Acquired with a Remidio Fundus on Phone. CFP:
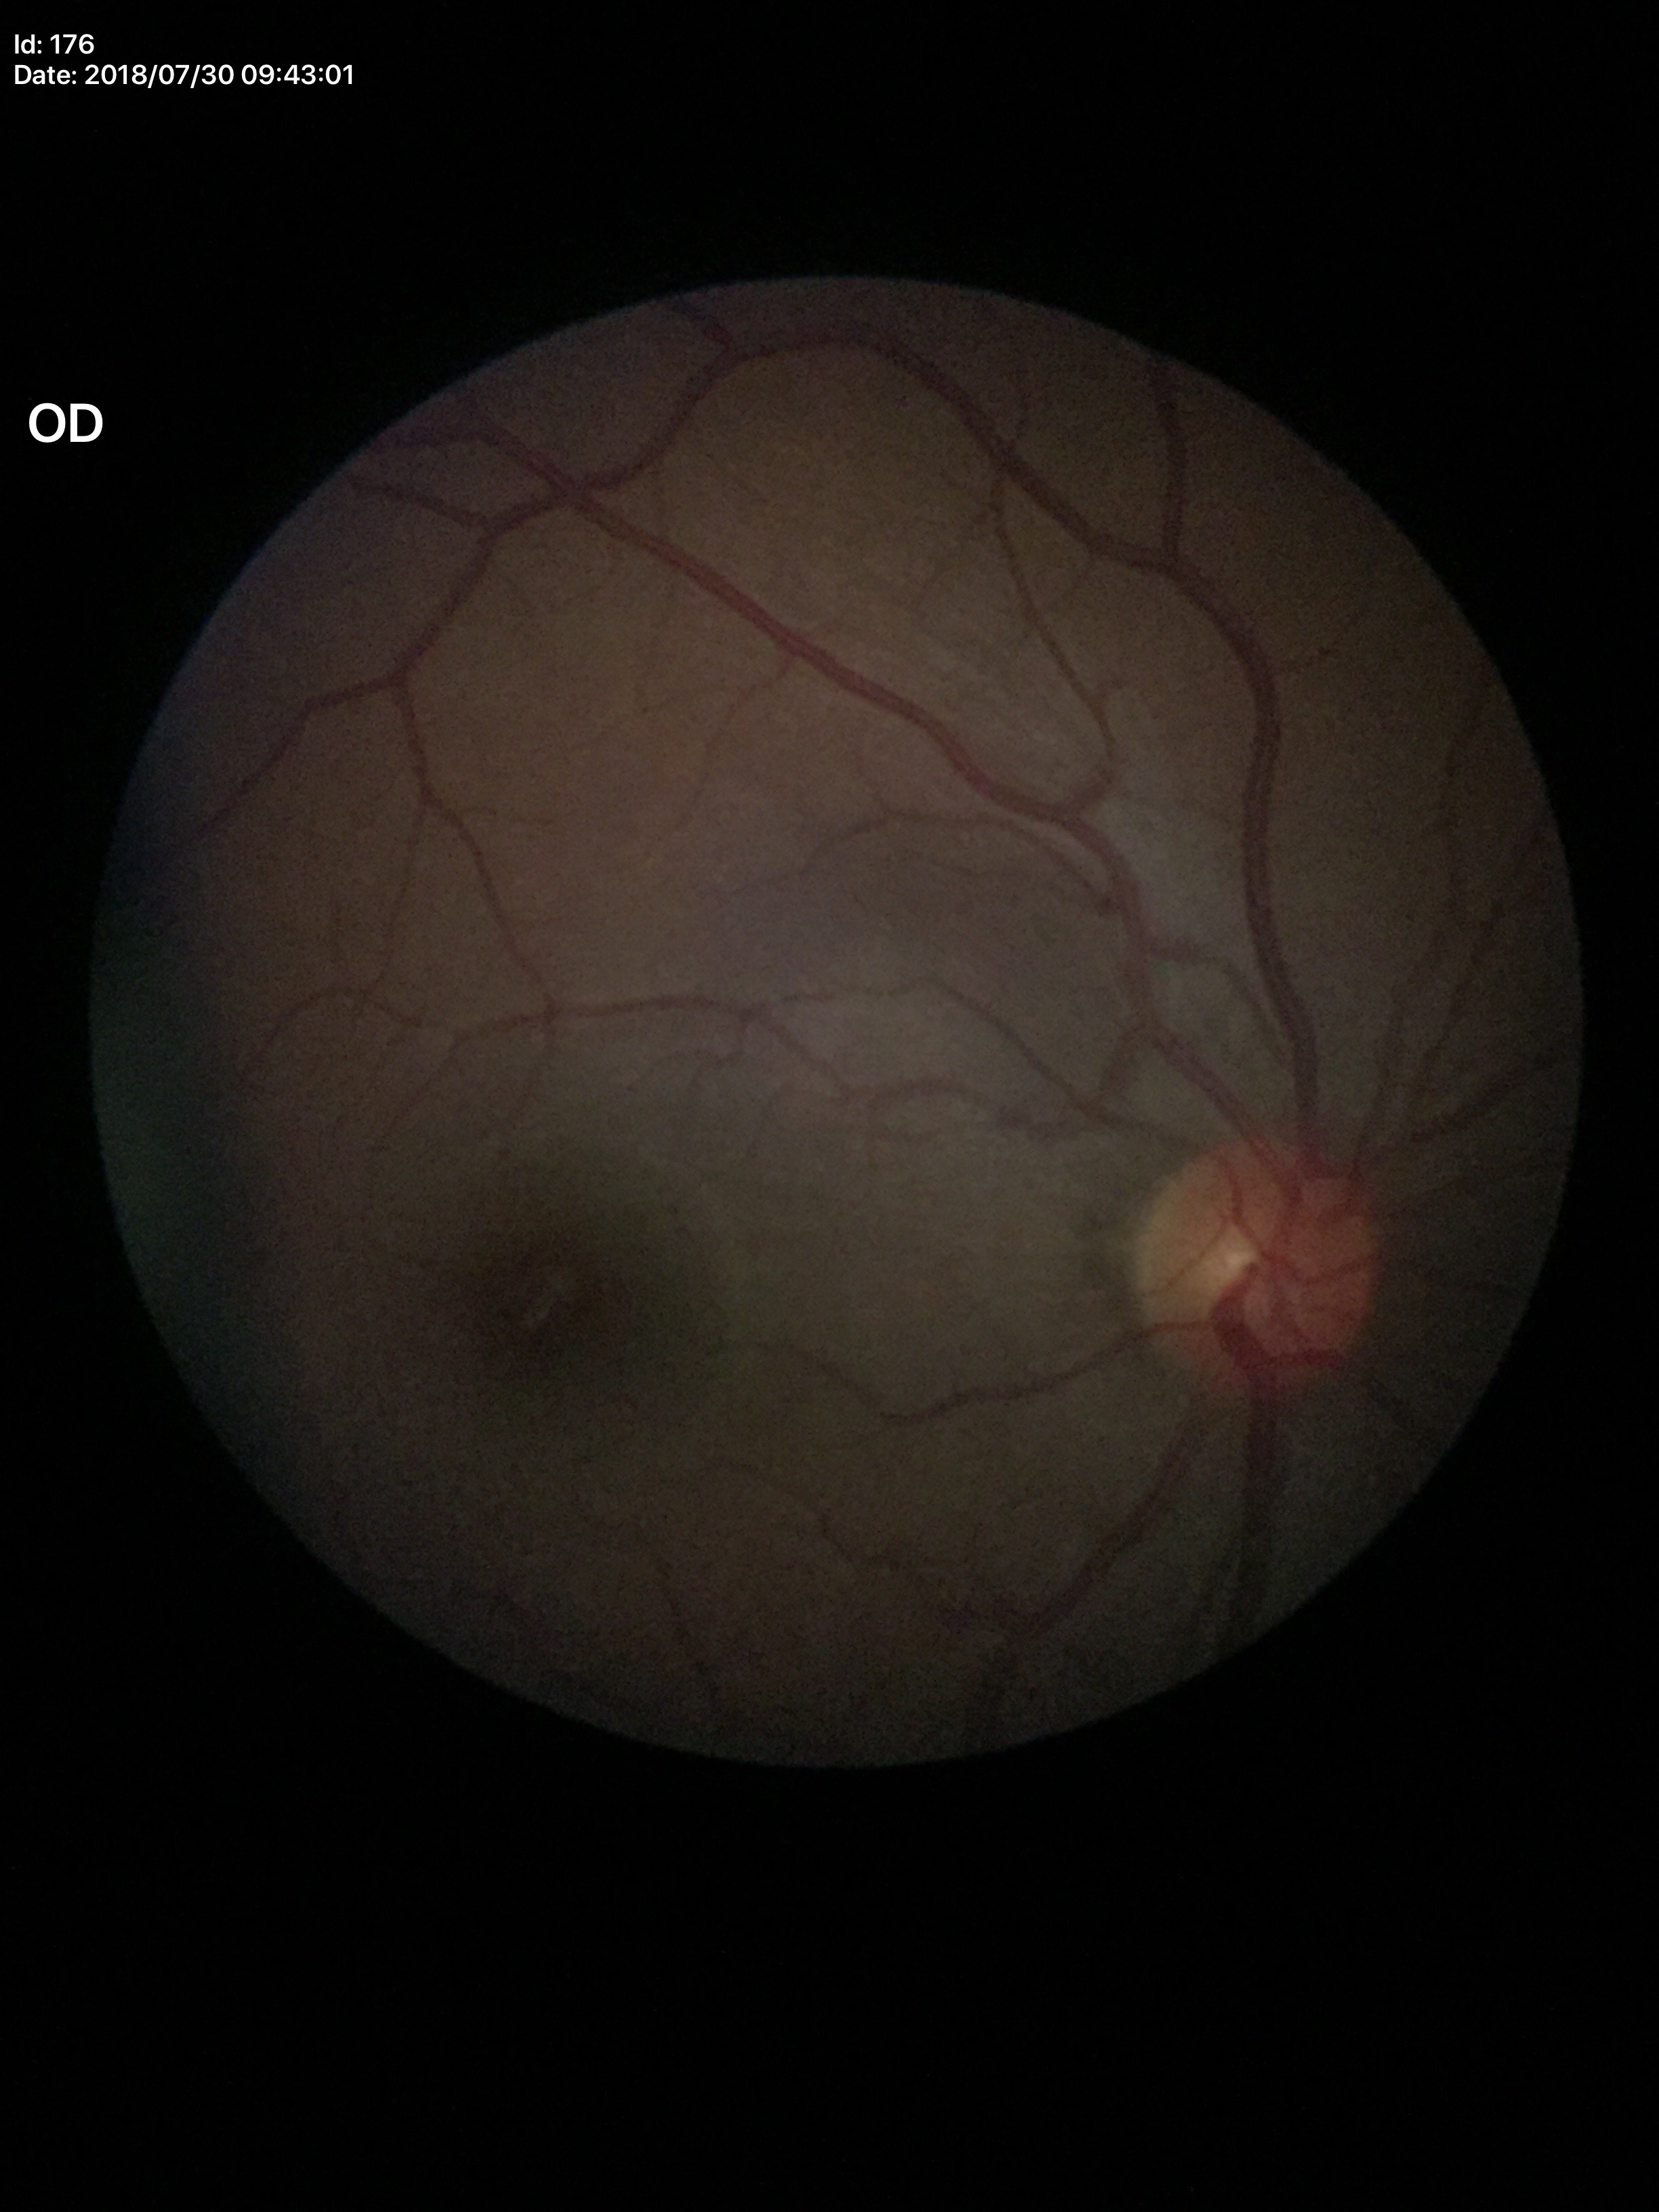
Negative for glaucoma suspicion. VCDR: 0.41. HCDR is 0.40.